1240 by 1240 pixels; captured with the Phoenix ICON (100° field of view); pediatric wide-field fundus photograph — 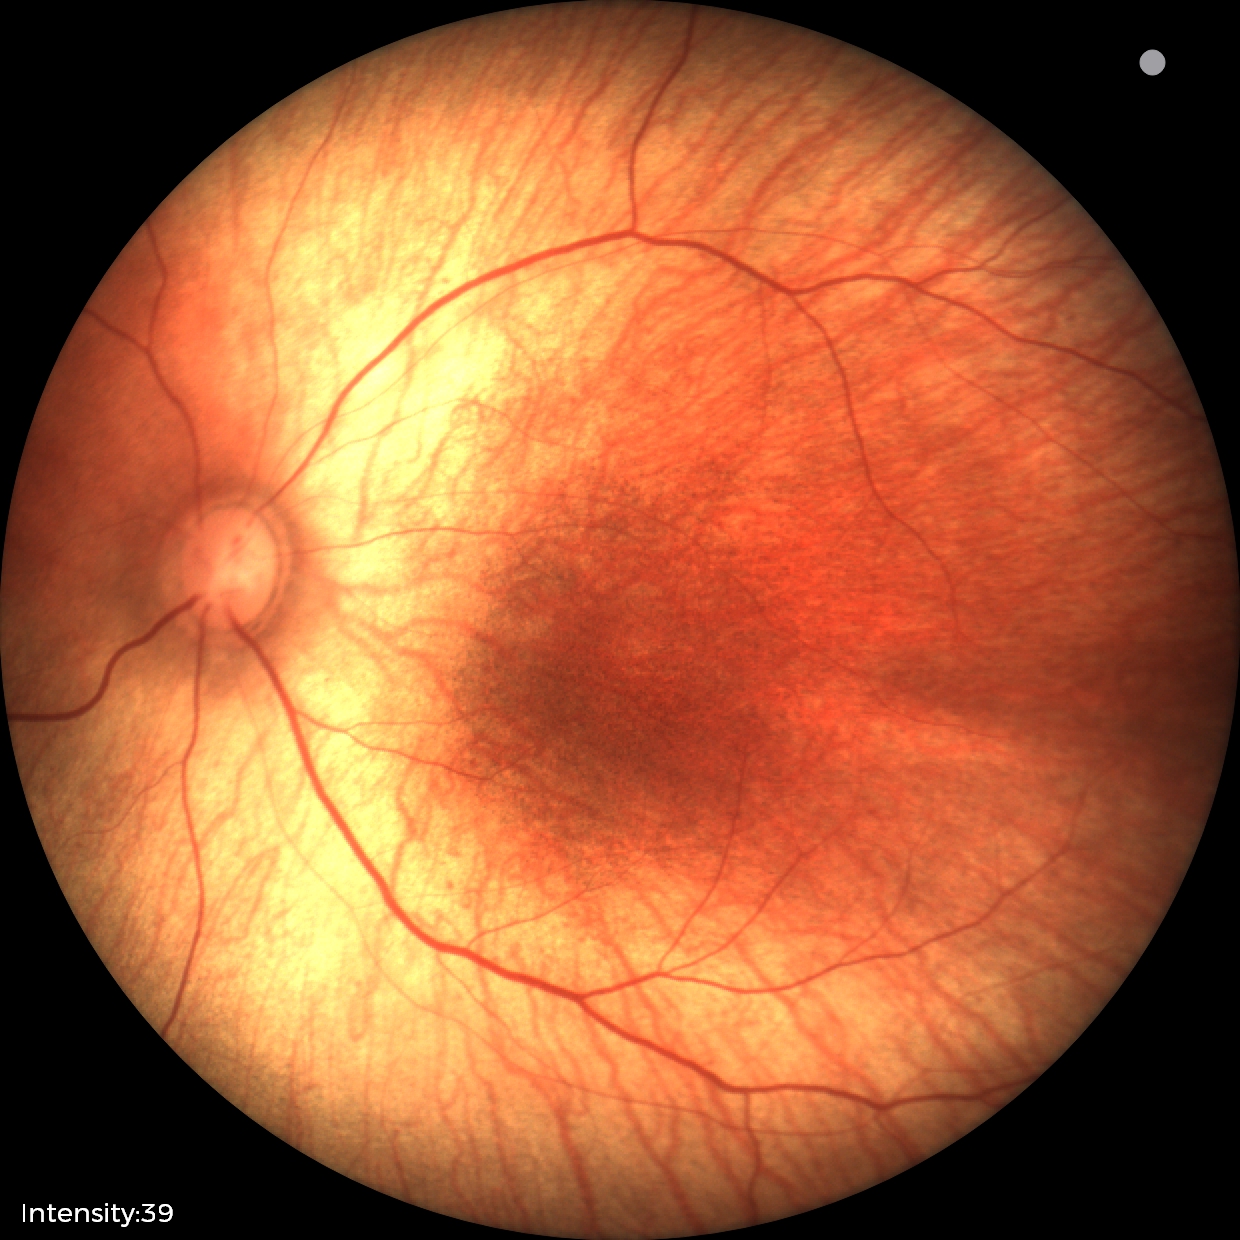

Examination with physiological retinal findings.